45-degree field of view. Retinal fundus photograph. 2048 by 1536 pixels.
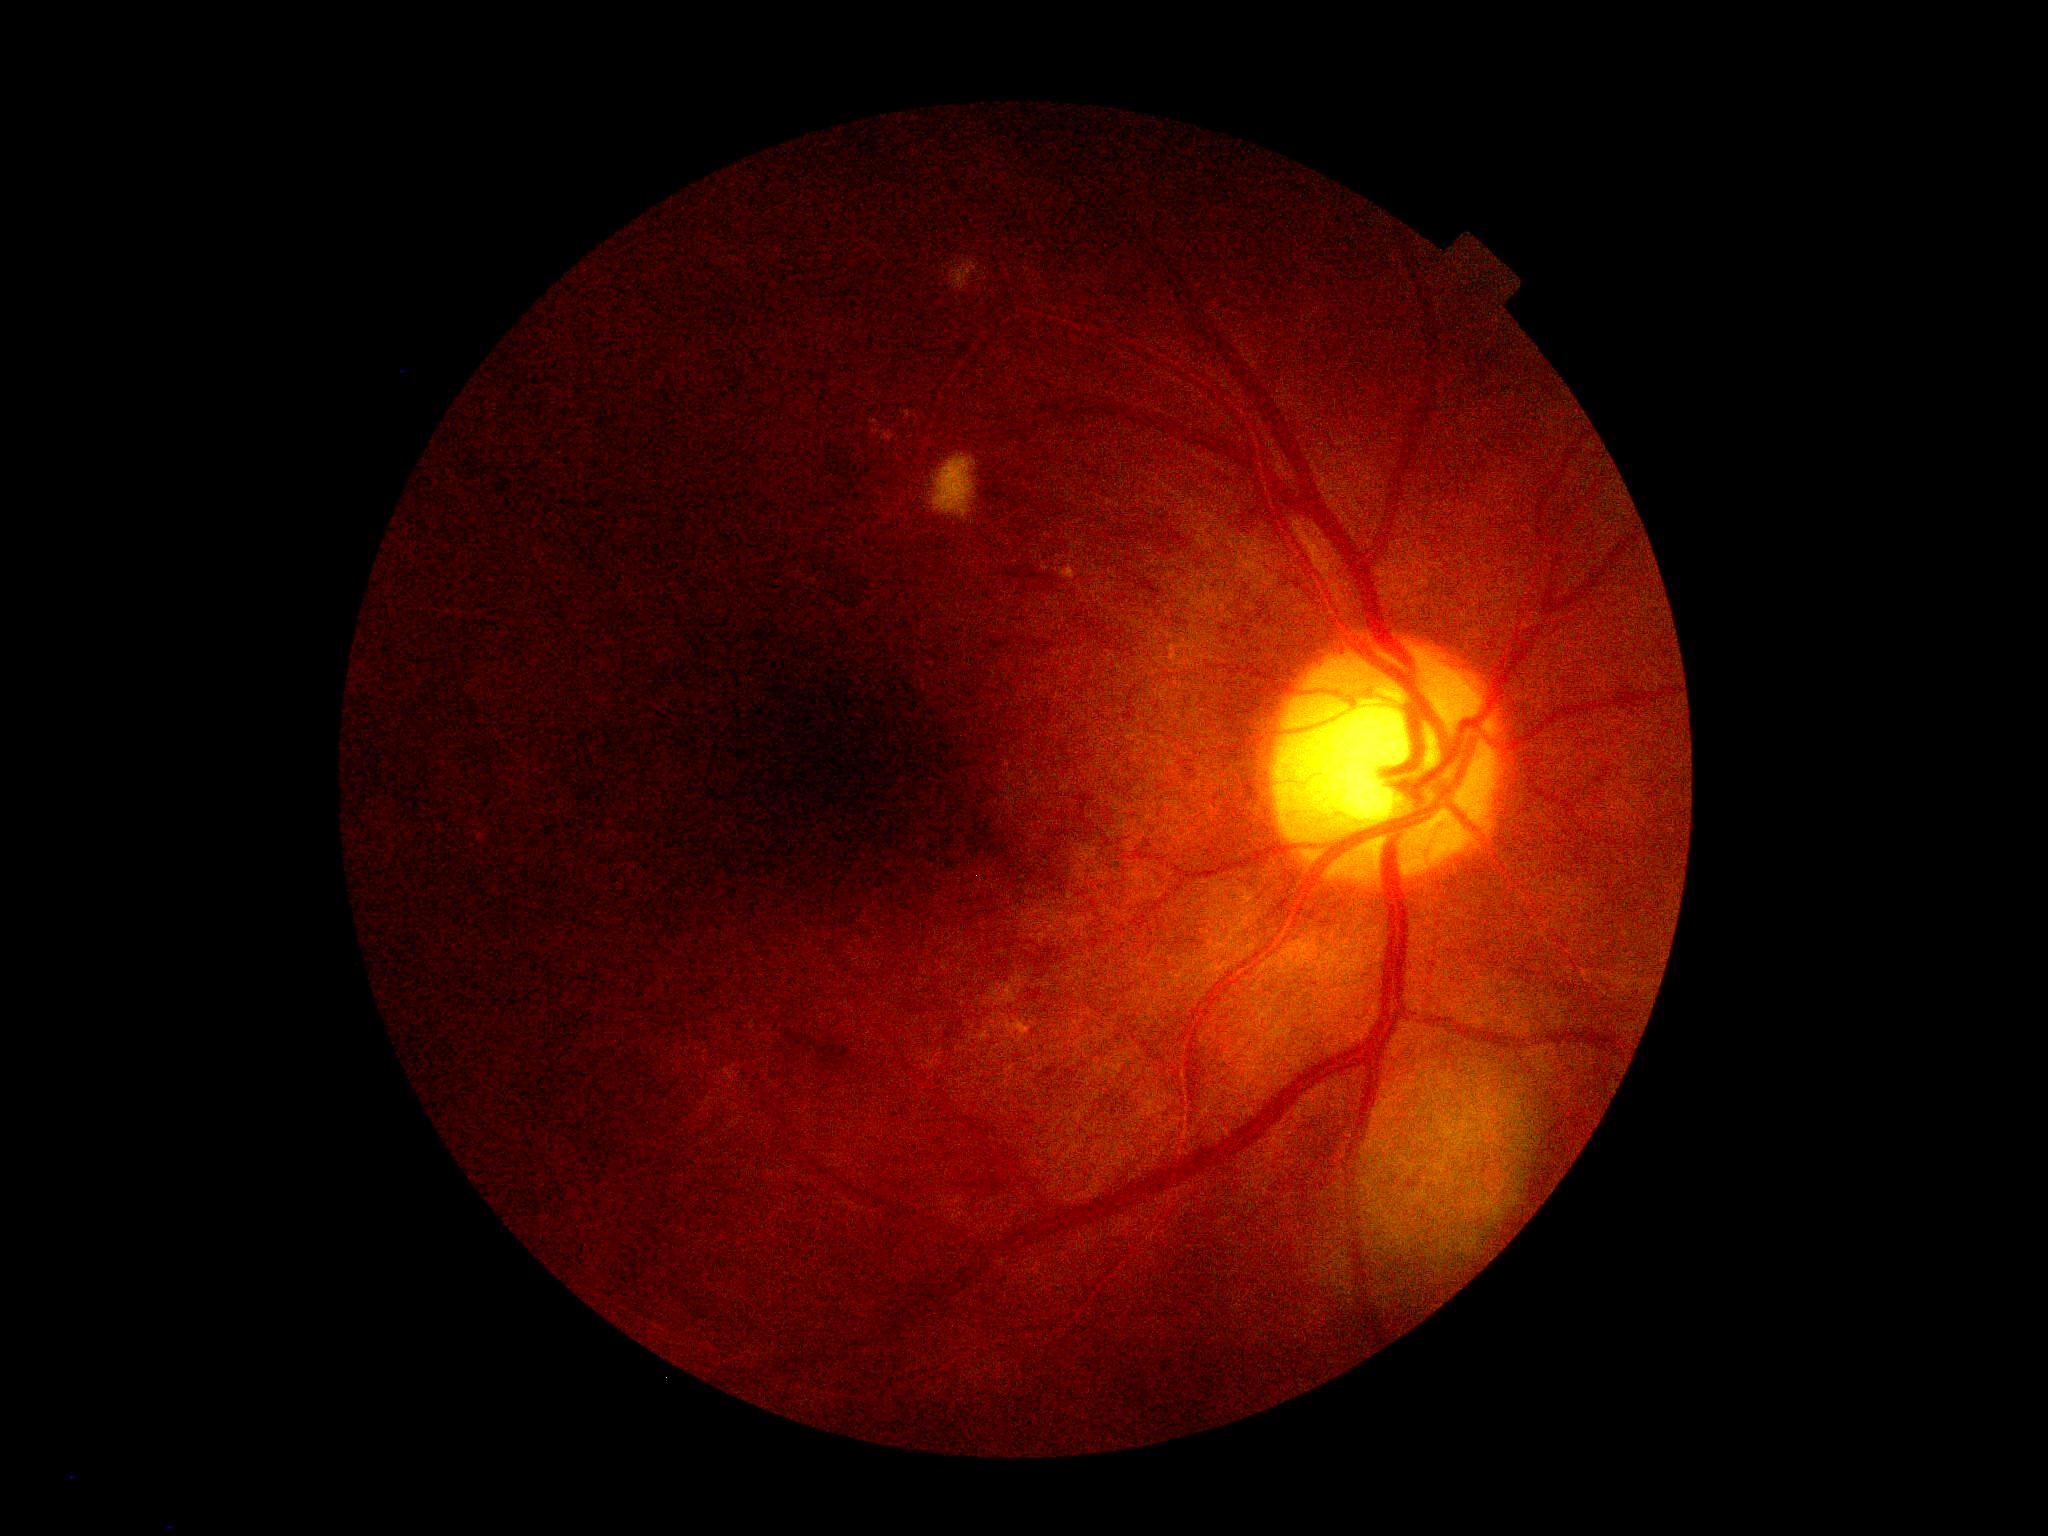   dr_category: non-proliferative diabetic retinopathy
  dr_grade: 2